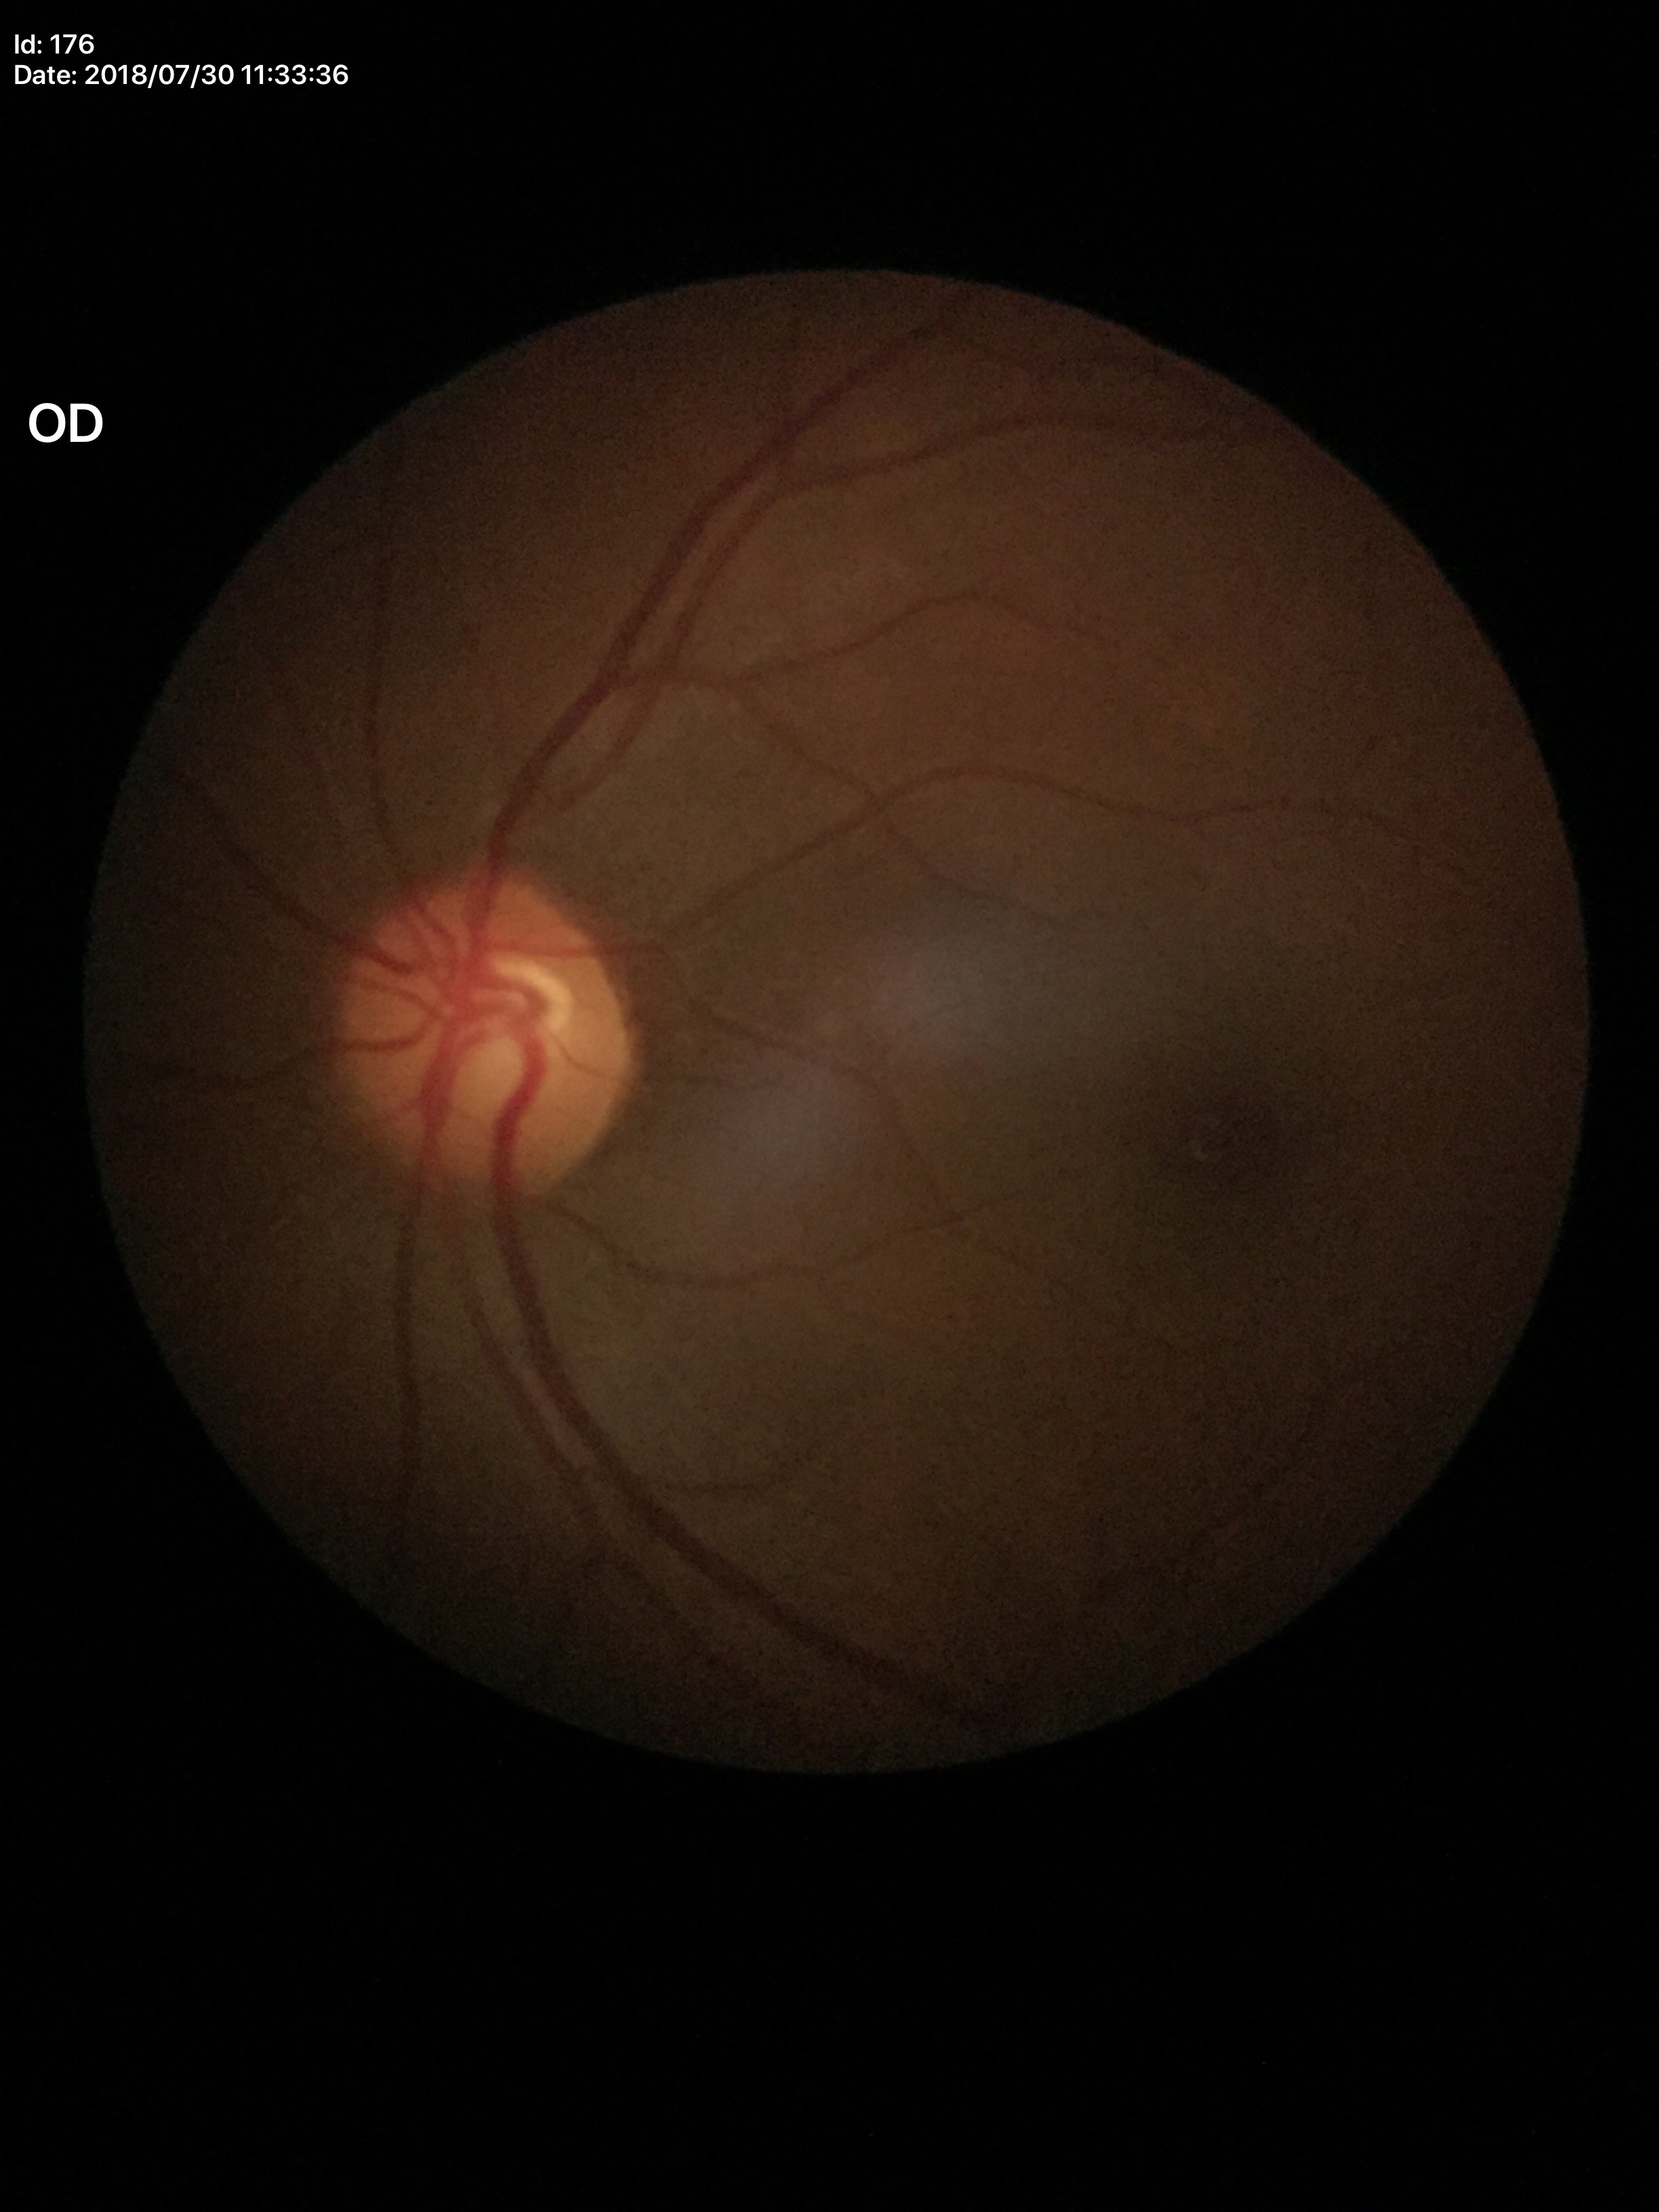 Vertical cup-to-disc ratio (VCDR) is 0.51.
No glaucomatous findings.